Image size 2228x1652. 50° field of view. Central posterior field:
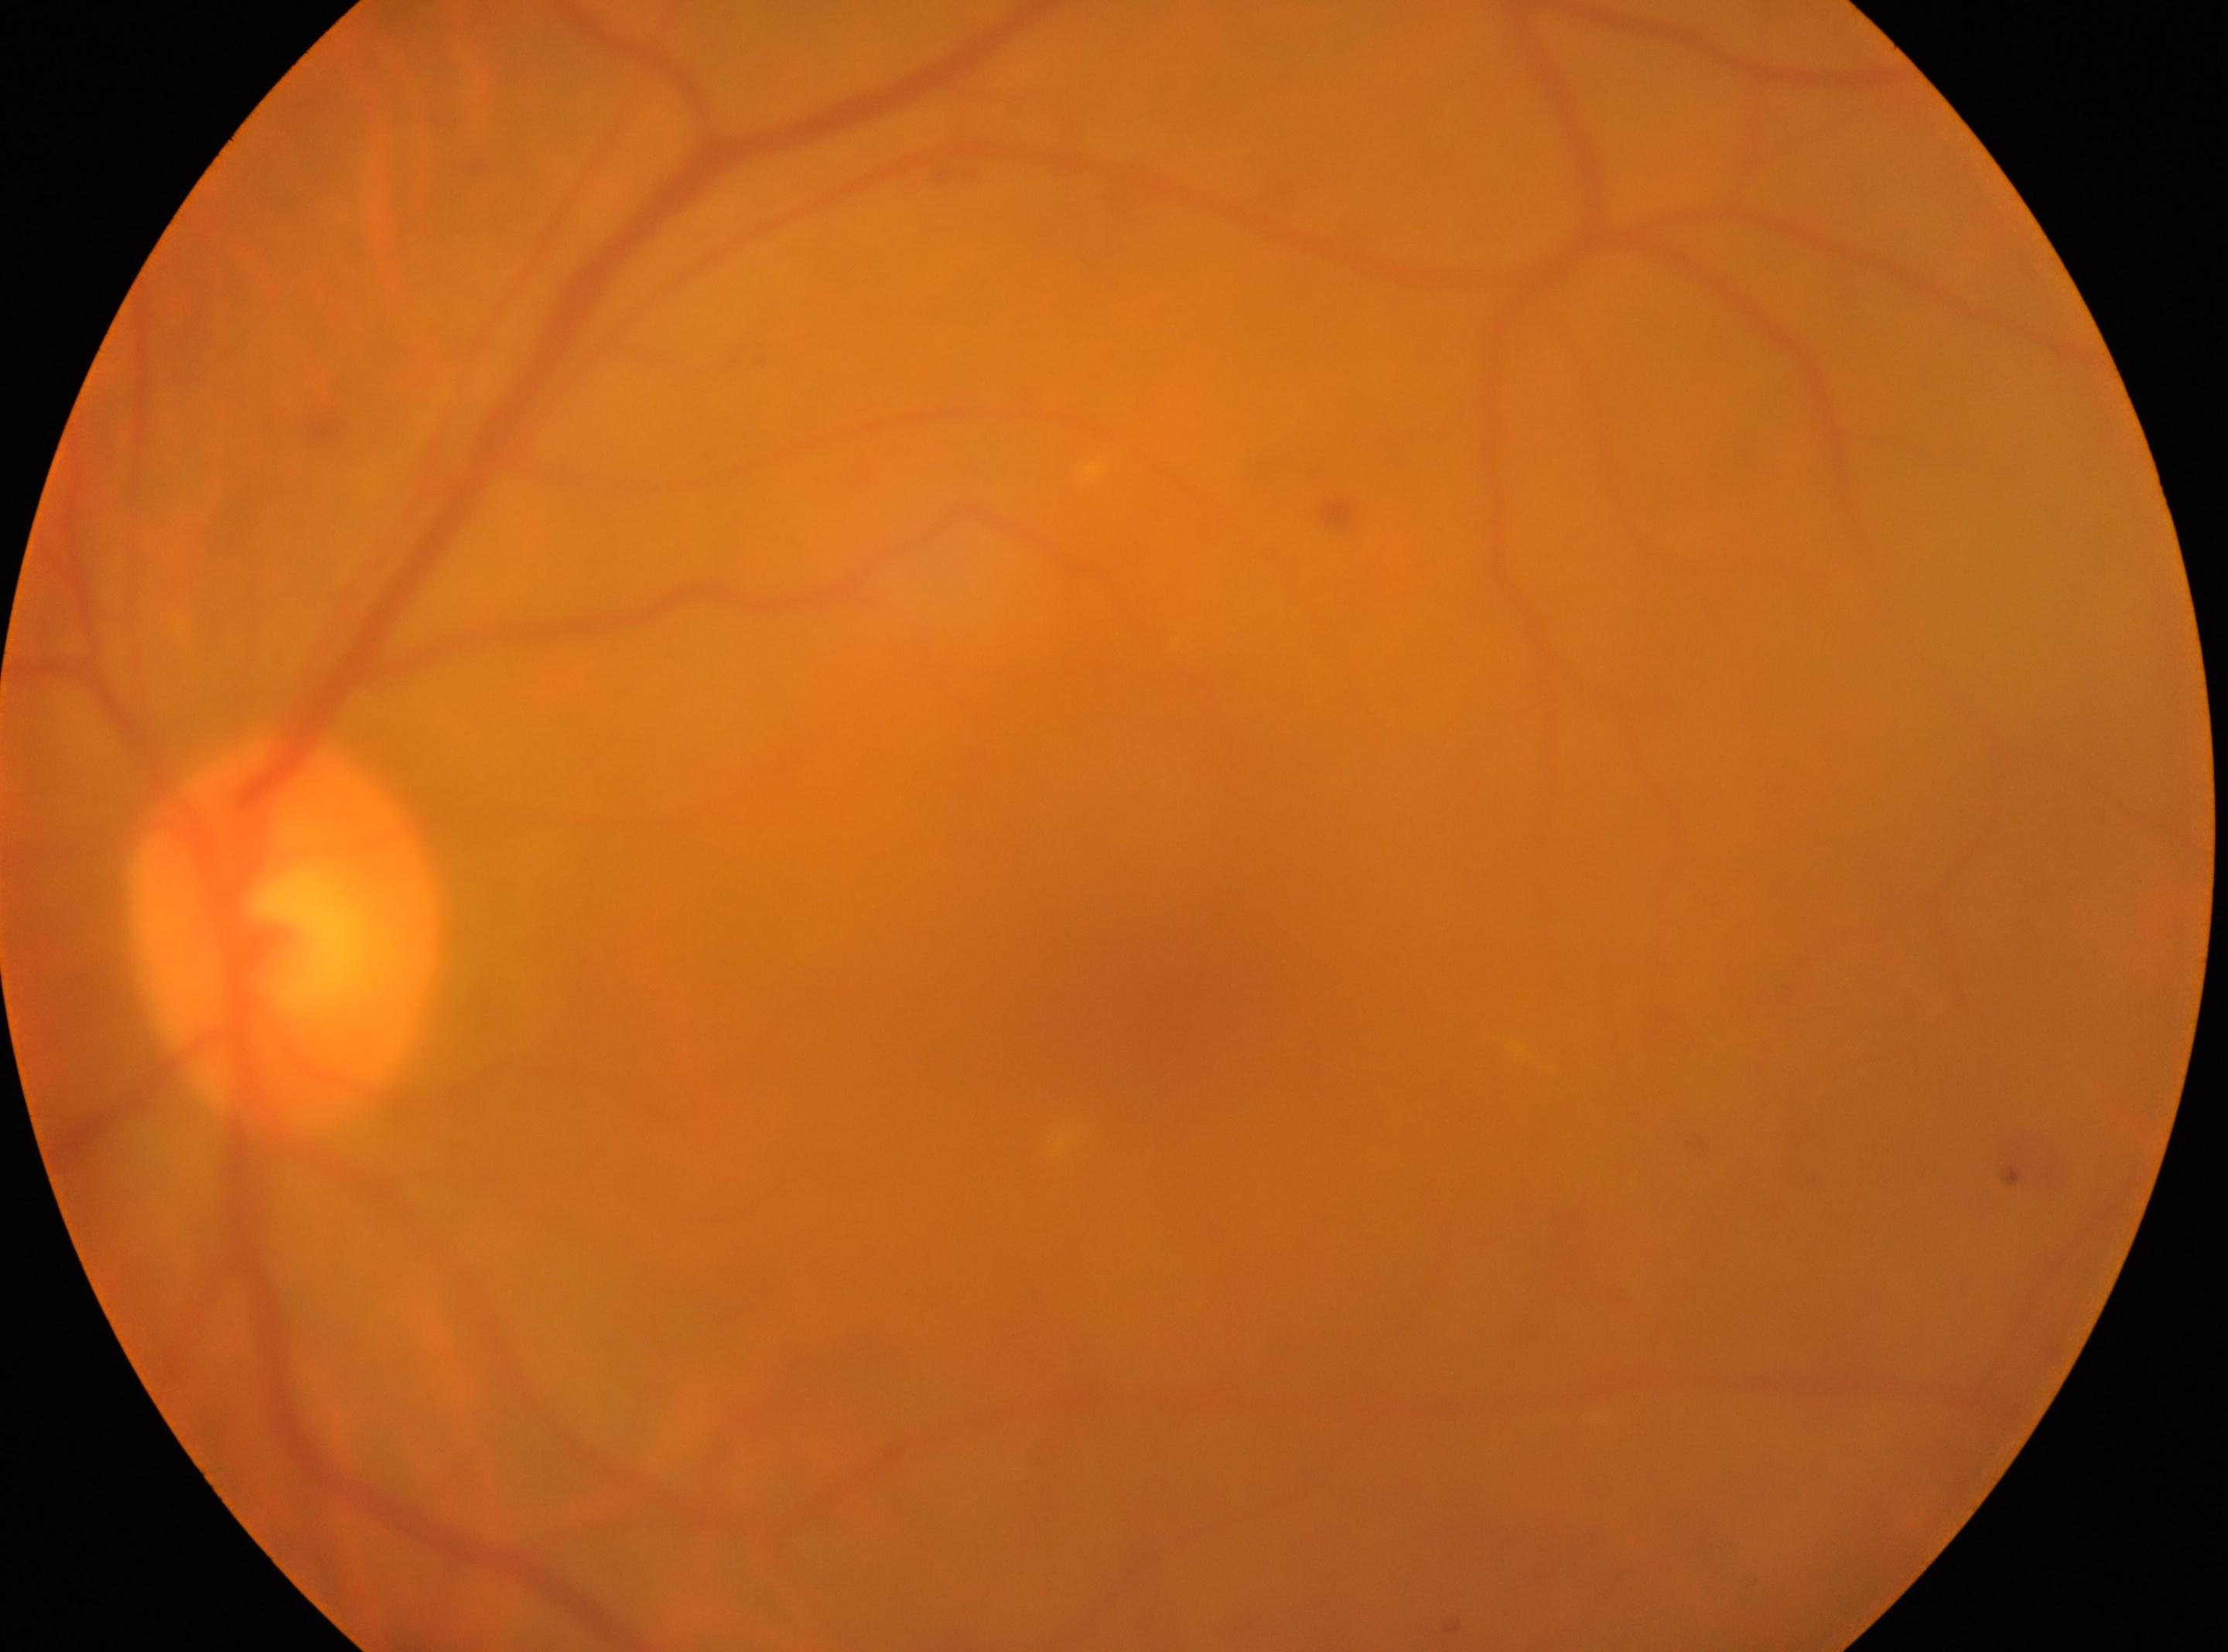 Findings:
– DR severity: moderate non-proliferative diabetic retinopathy (grade 2)
– fovea: 1202px, 1035px
– laterality: left eye
– optic disc: 285px, 934px